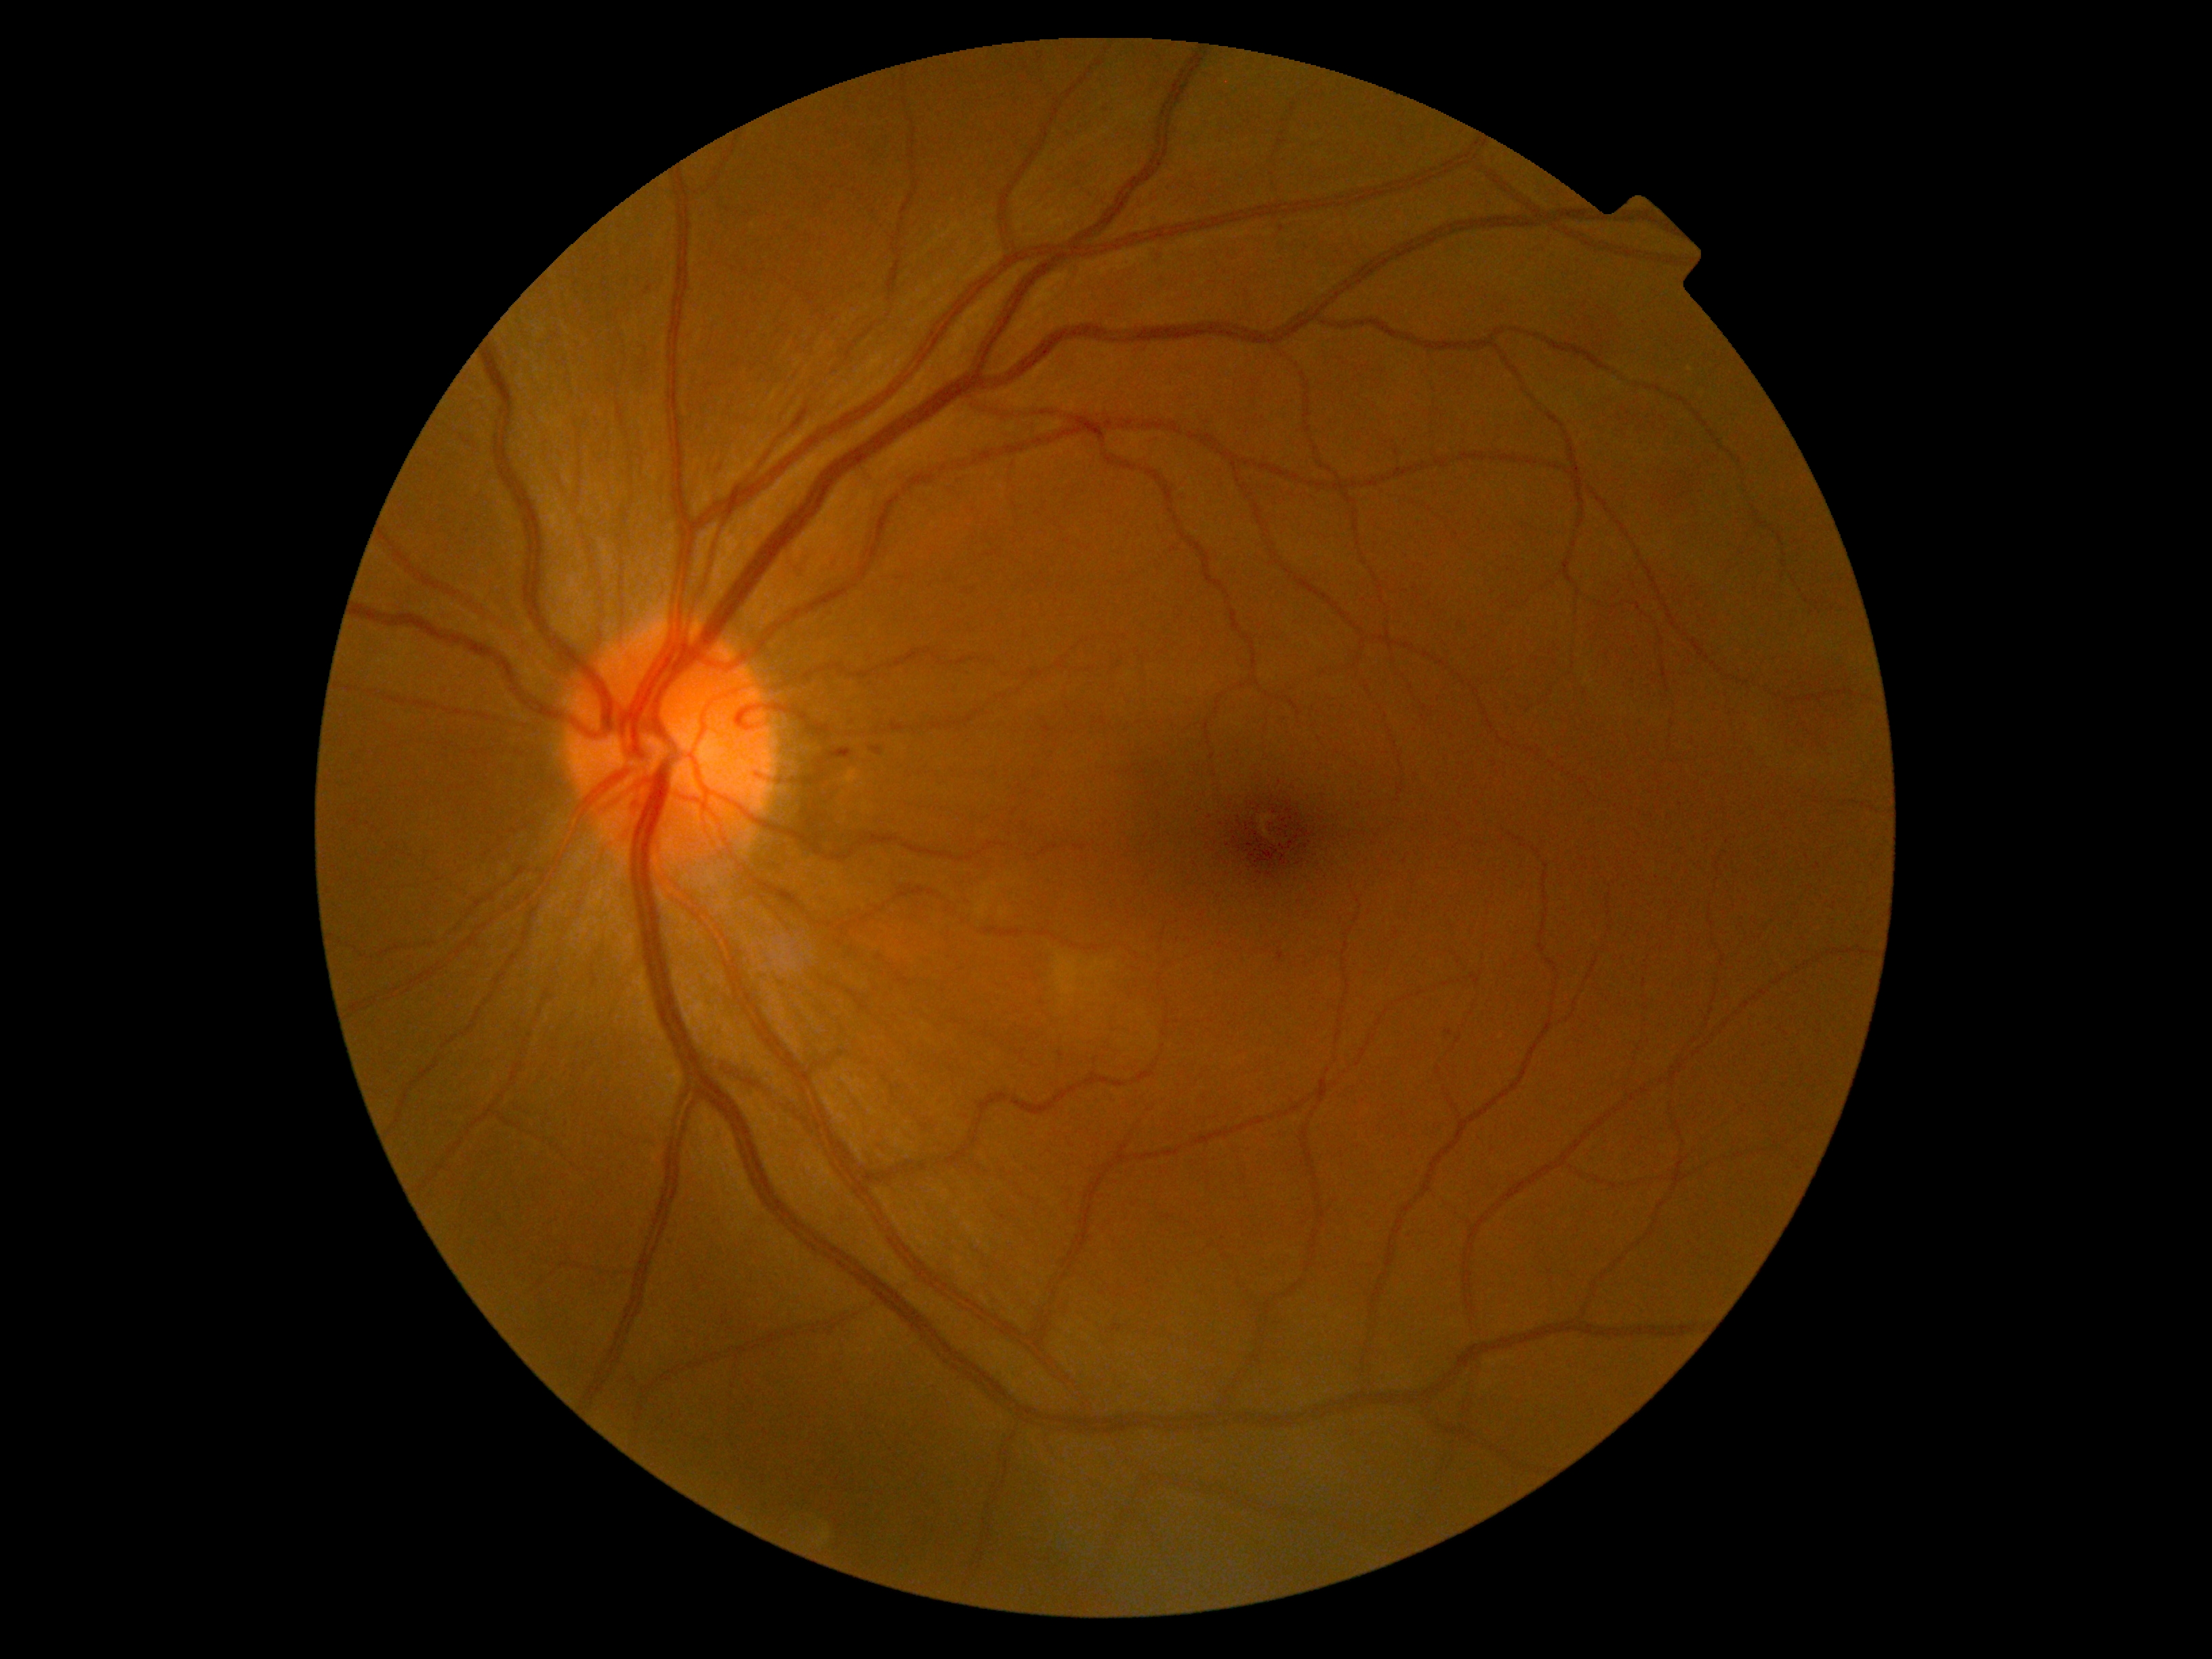   dr_grade: 1 (mild NPDR)
  dr_category: non-proliferative diabetic retinopathy